45° field of view — 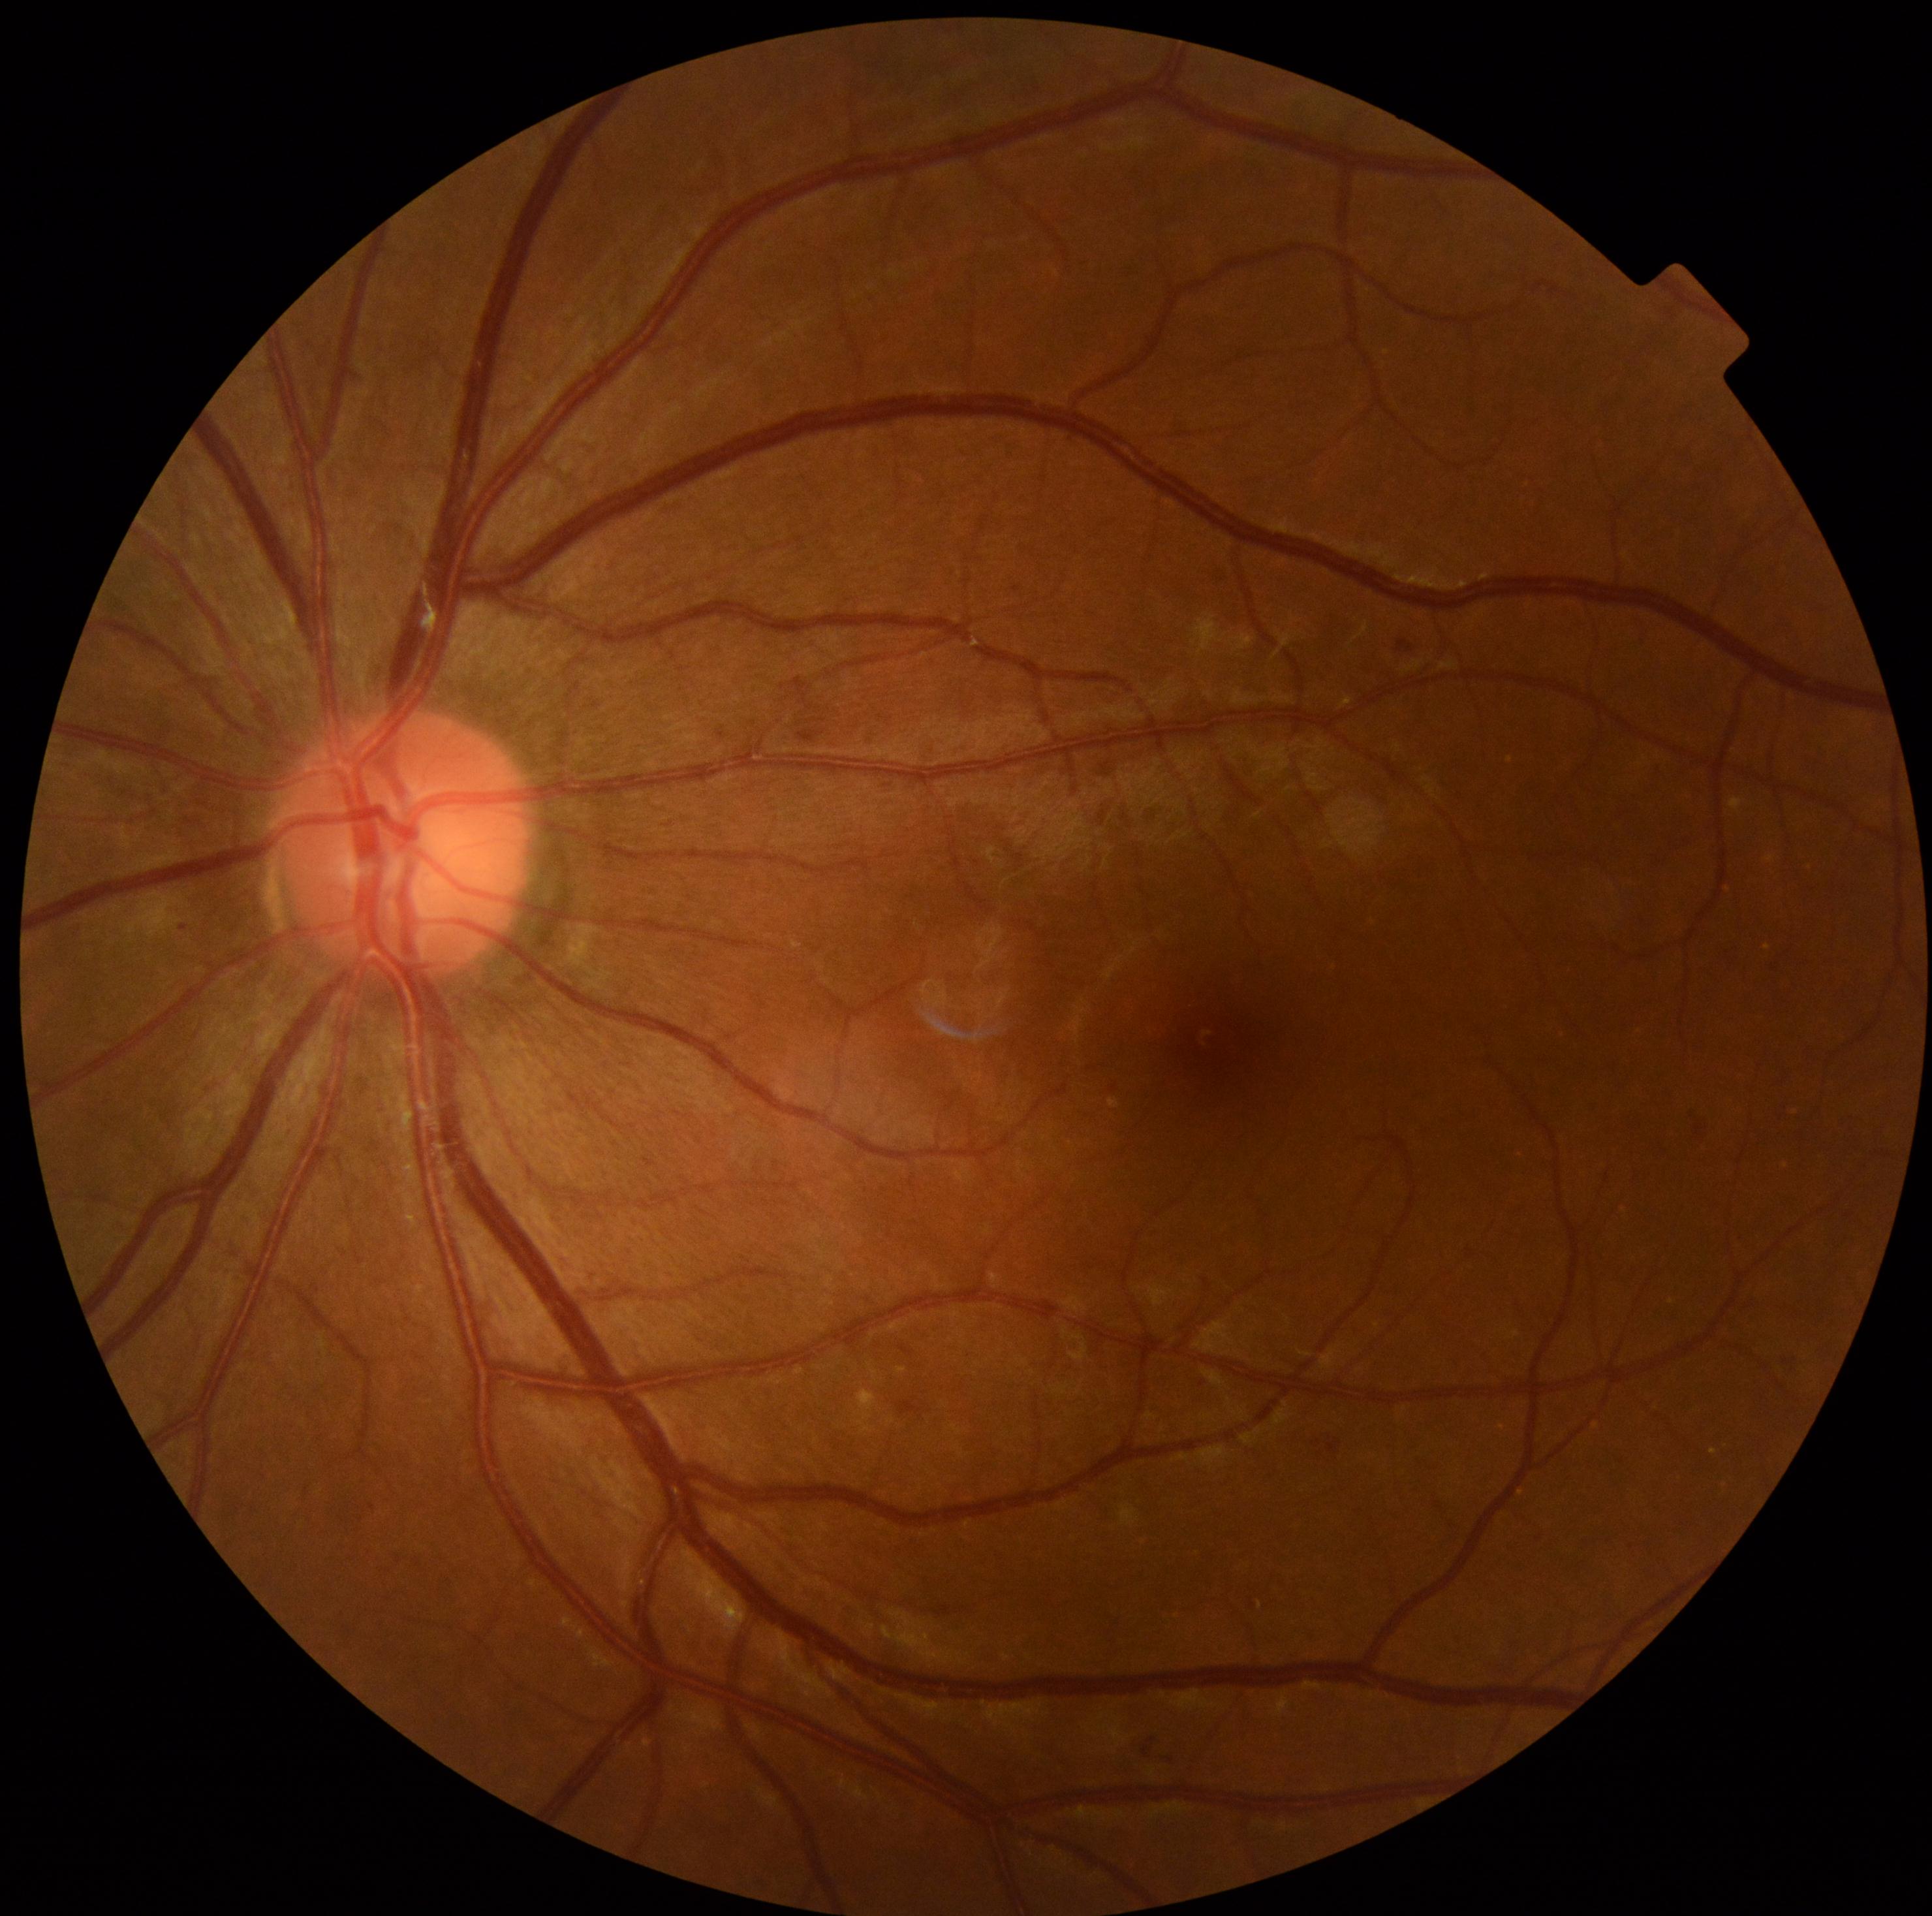 DR stage: 1/4.